45° field of view. 1932x1916px
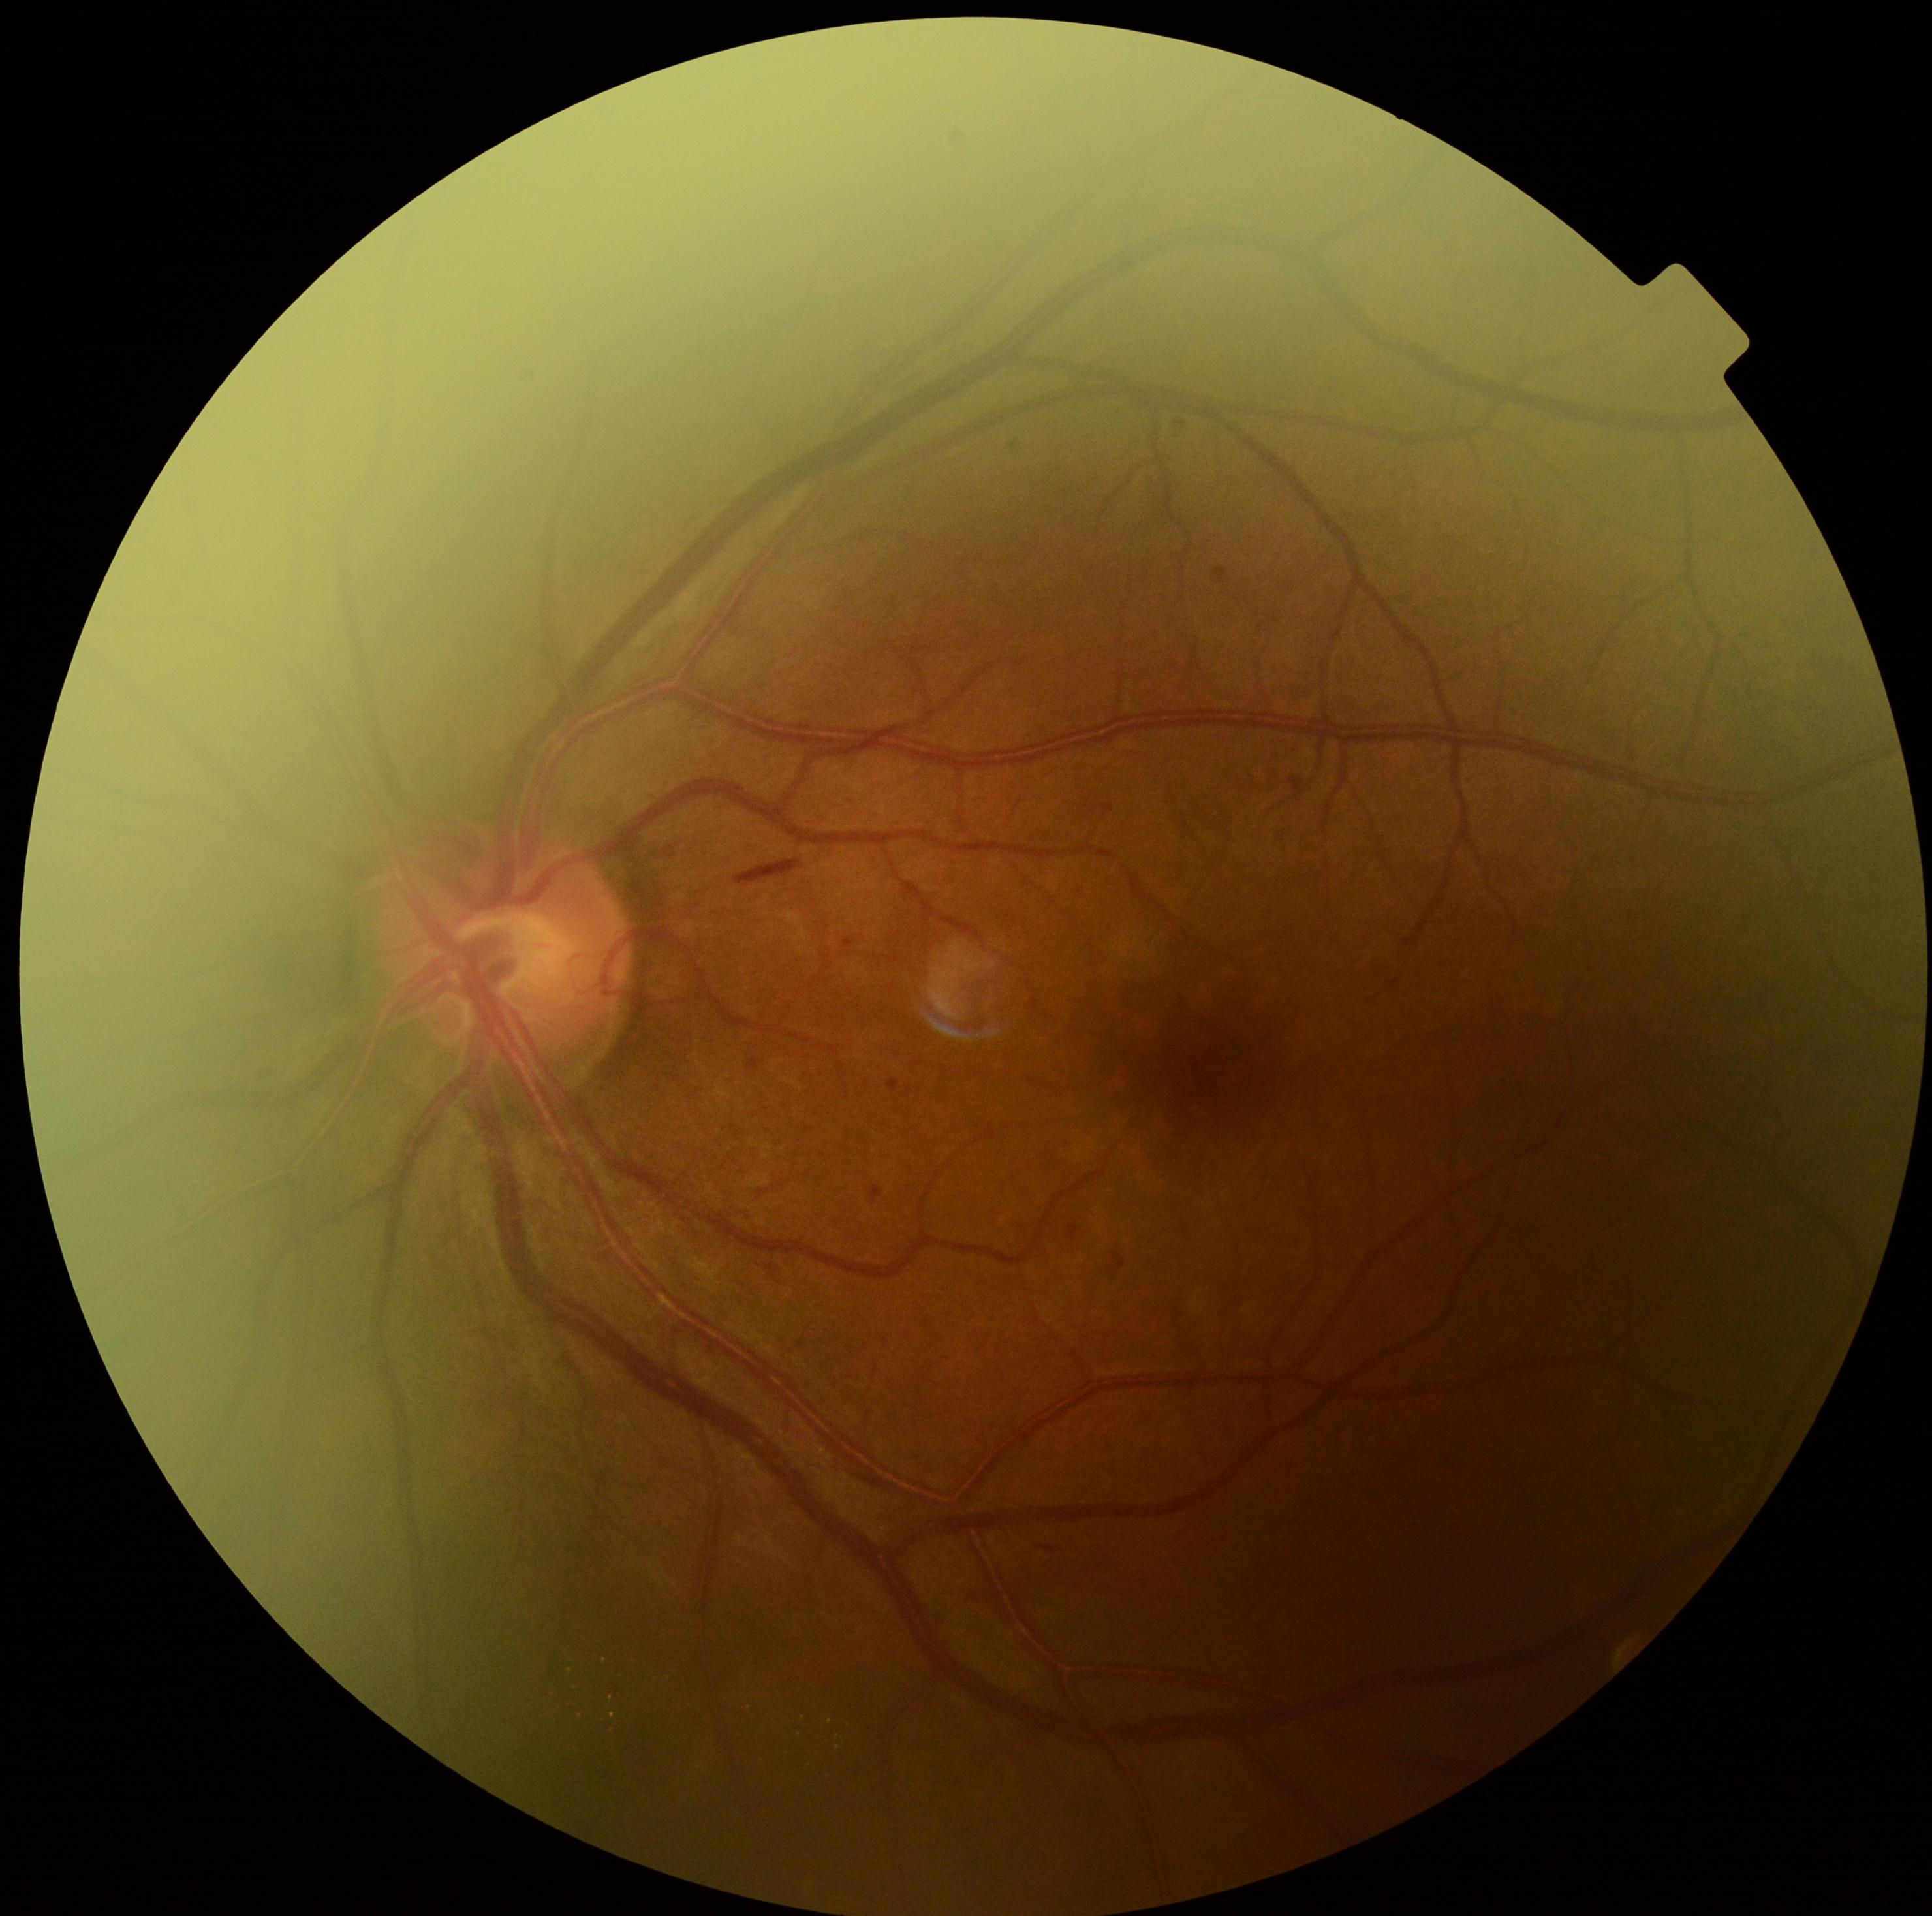 dr_grade: moderate NPDR (grade 2)